CFP — 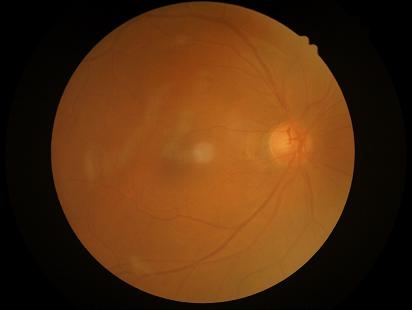
{
  "clarity": "reduced",
  "illumination": "adequate",
  "contrast": "adequate",
  "overall_quality": "suboptimal"
}